CFP
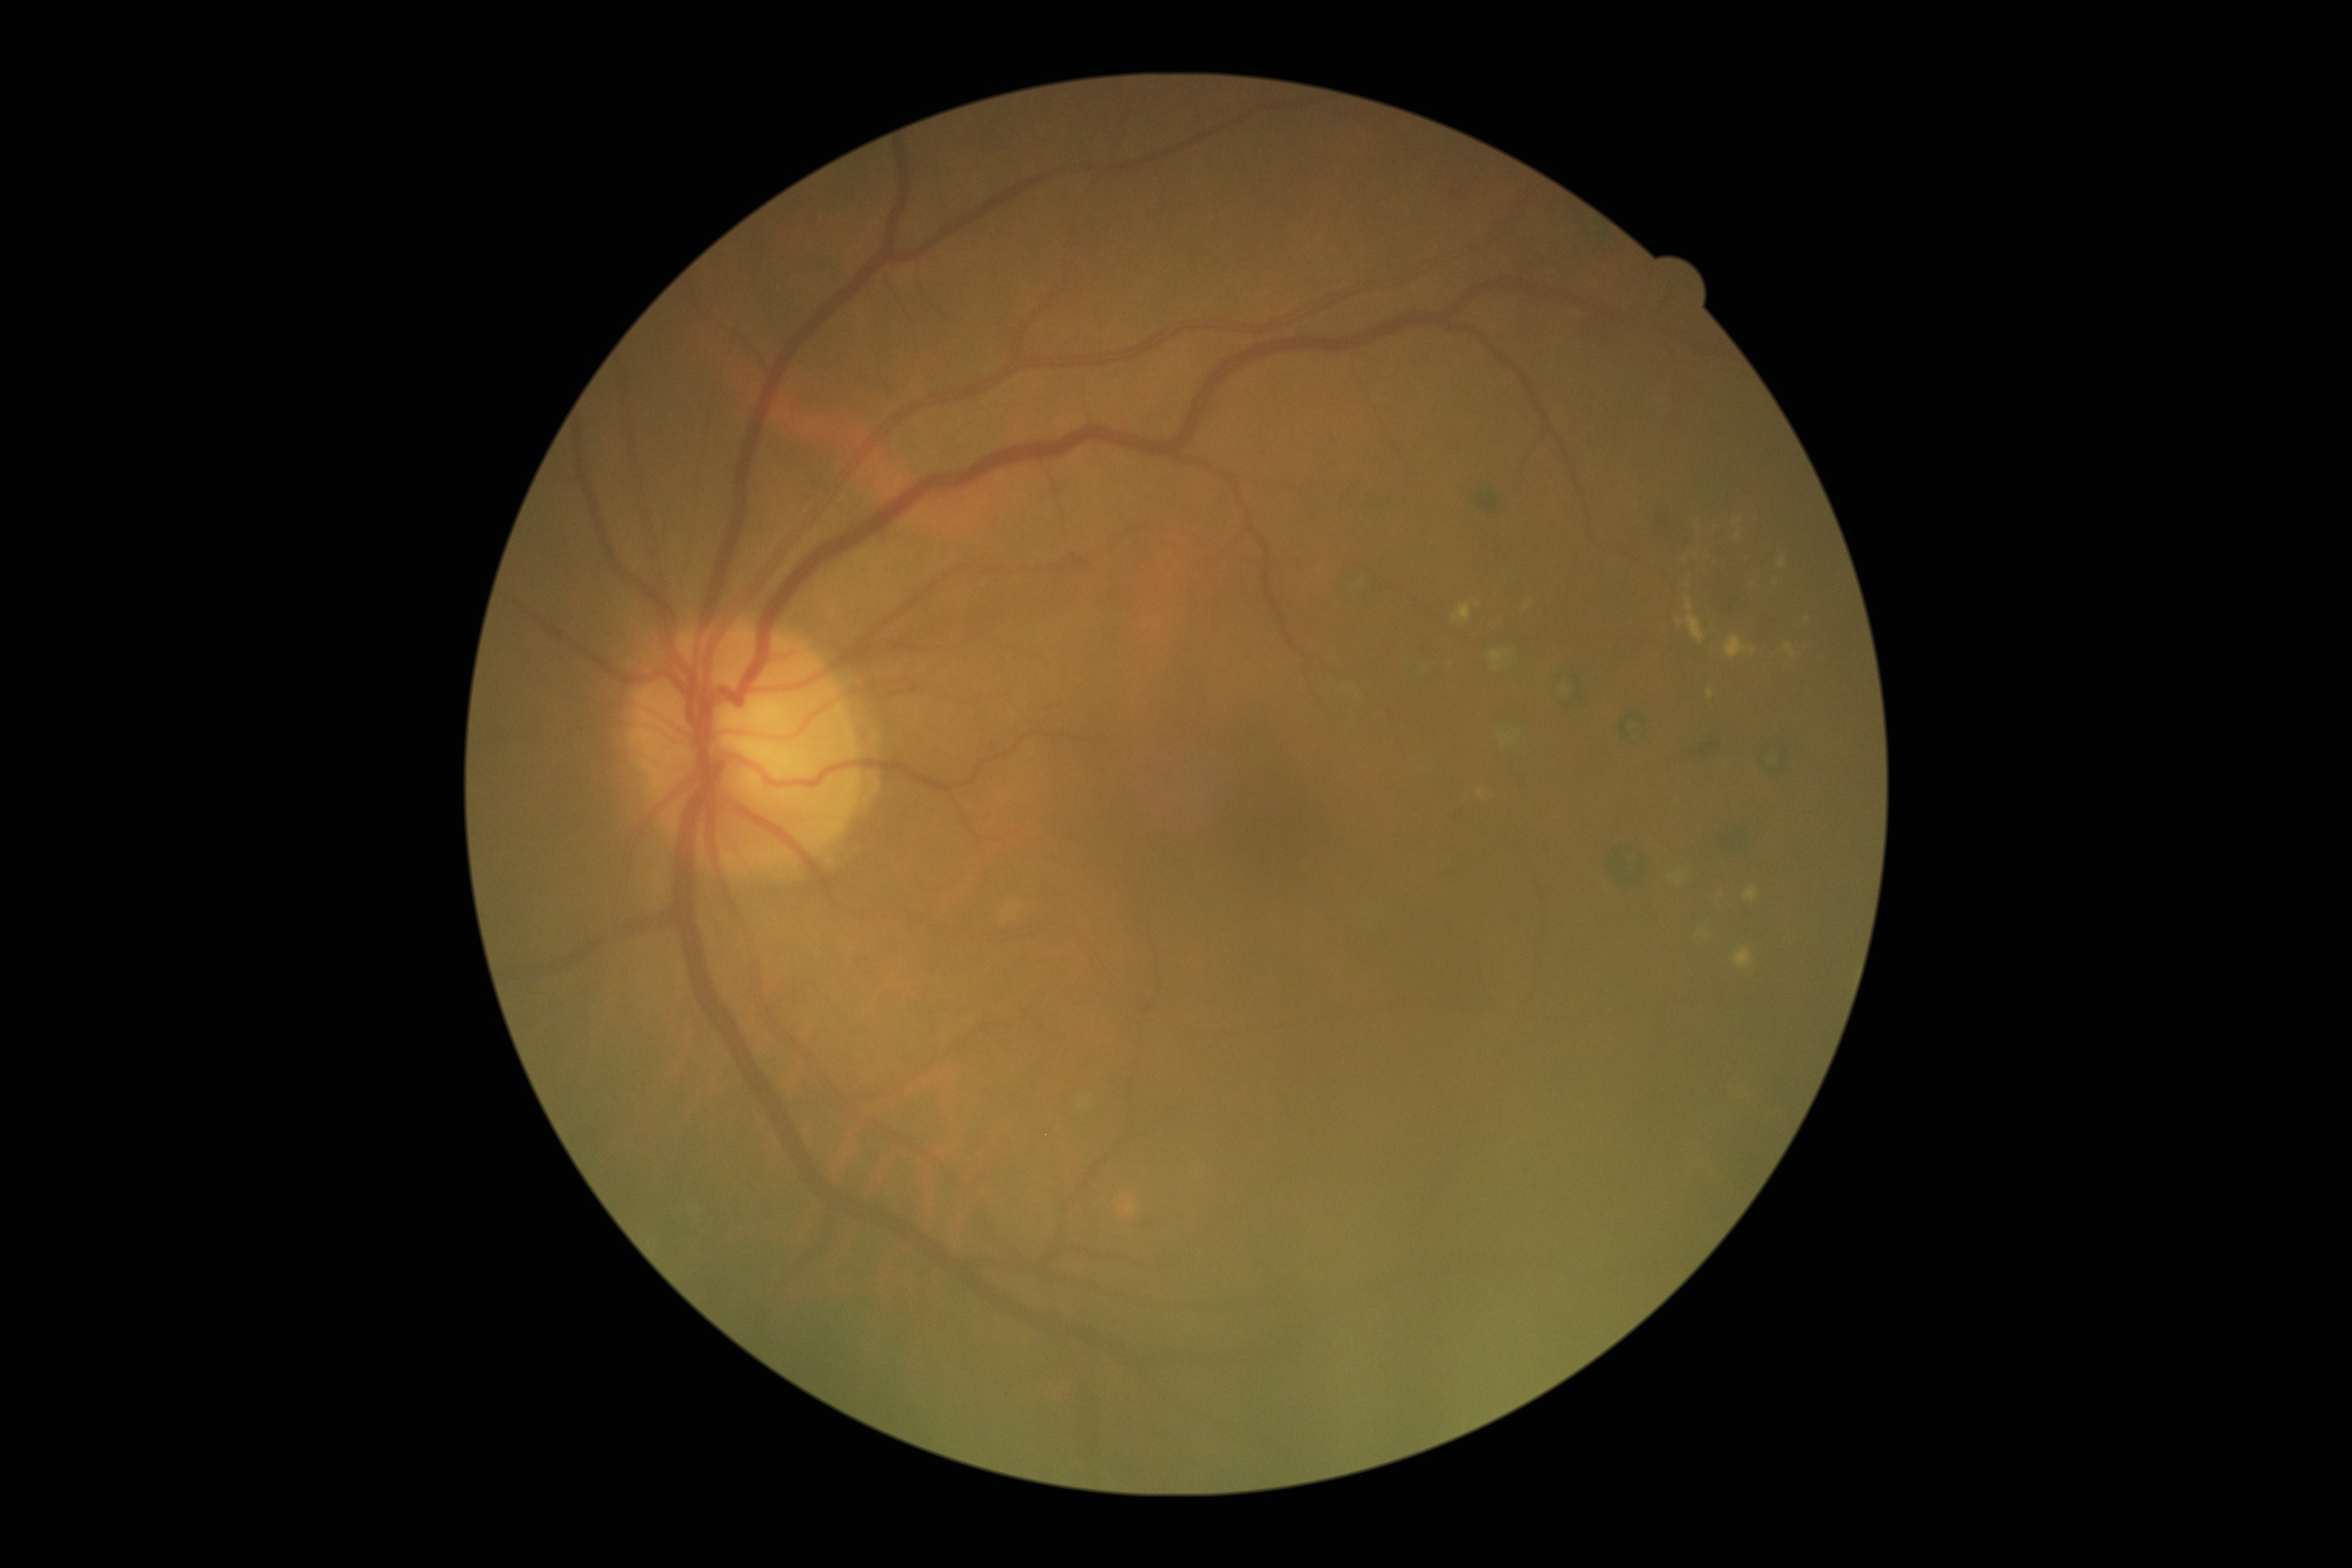 DR class: non-proliferative diabetic retinopathy, DR grade: 2 (moderate NPDR) — more than just microaneurysms but less than severe NPDR.